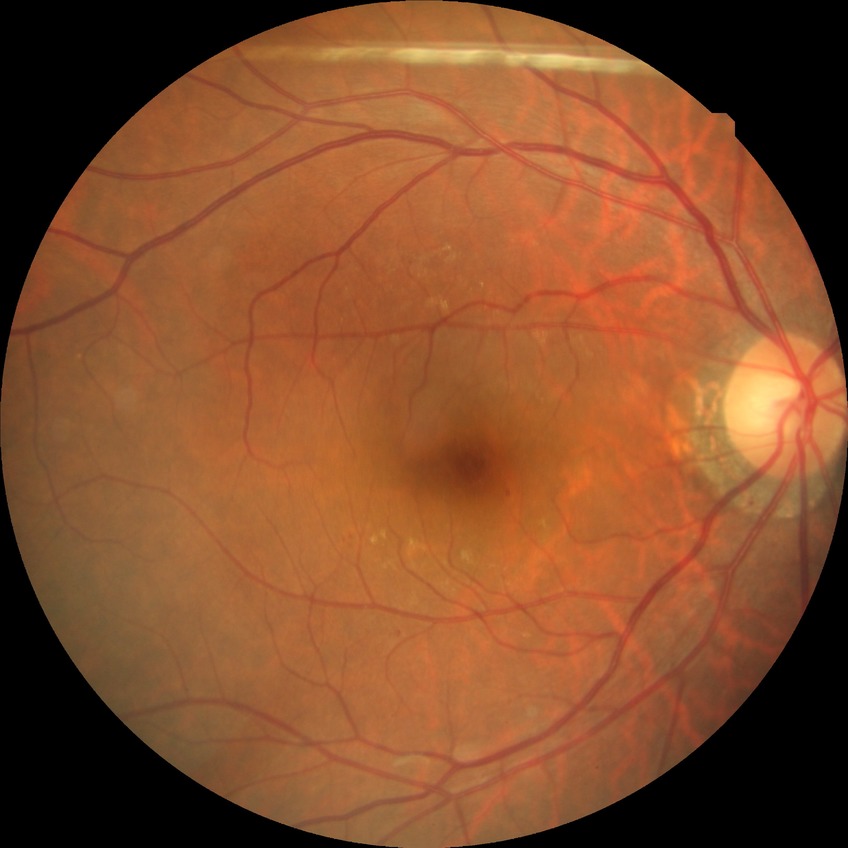

Modified Davis grading is no diabetic retinopathy.